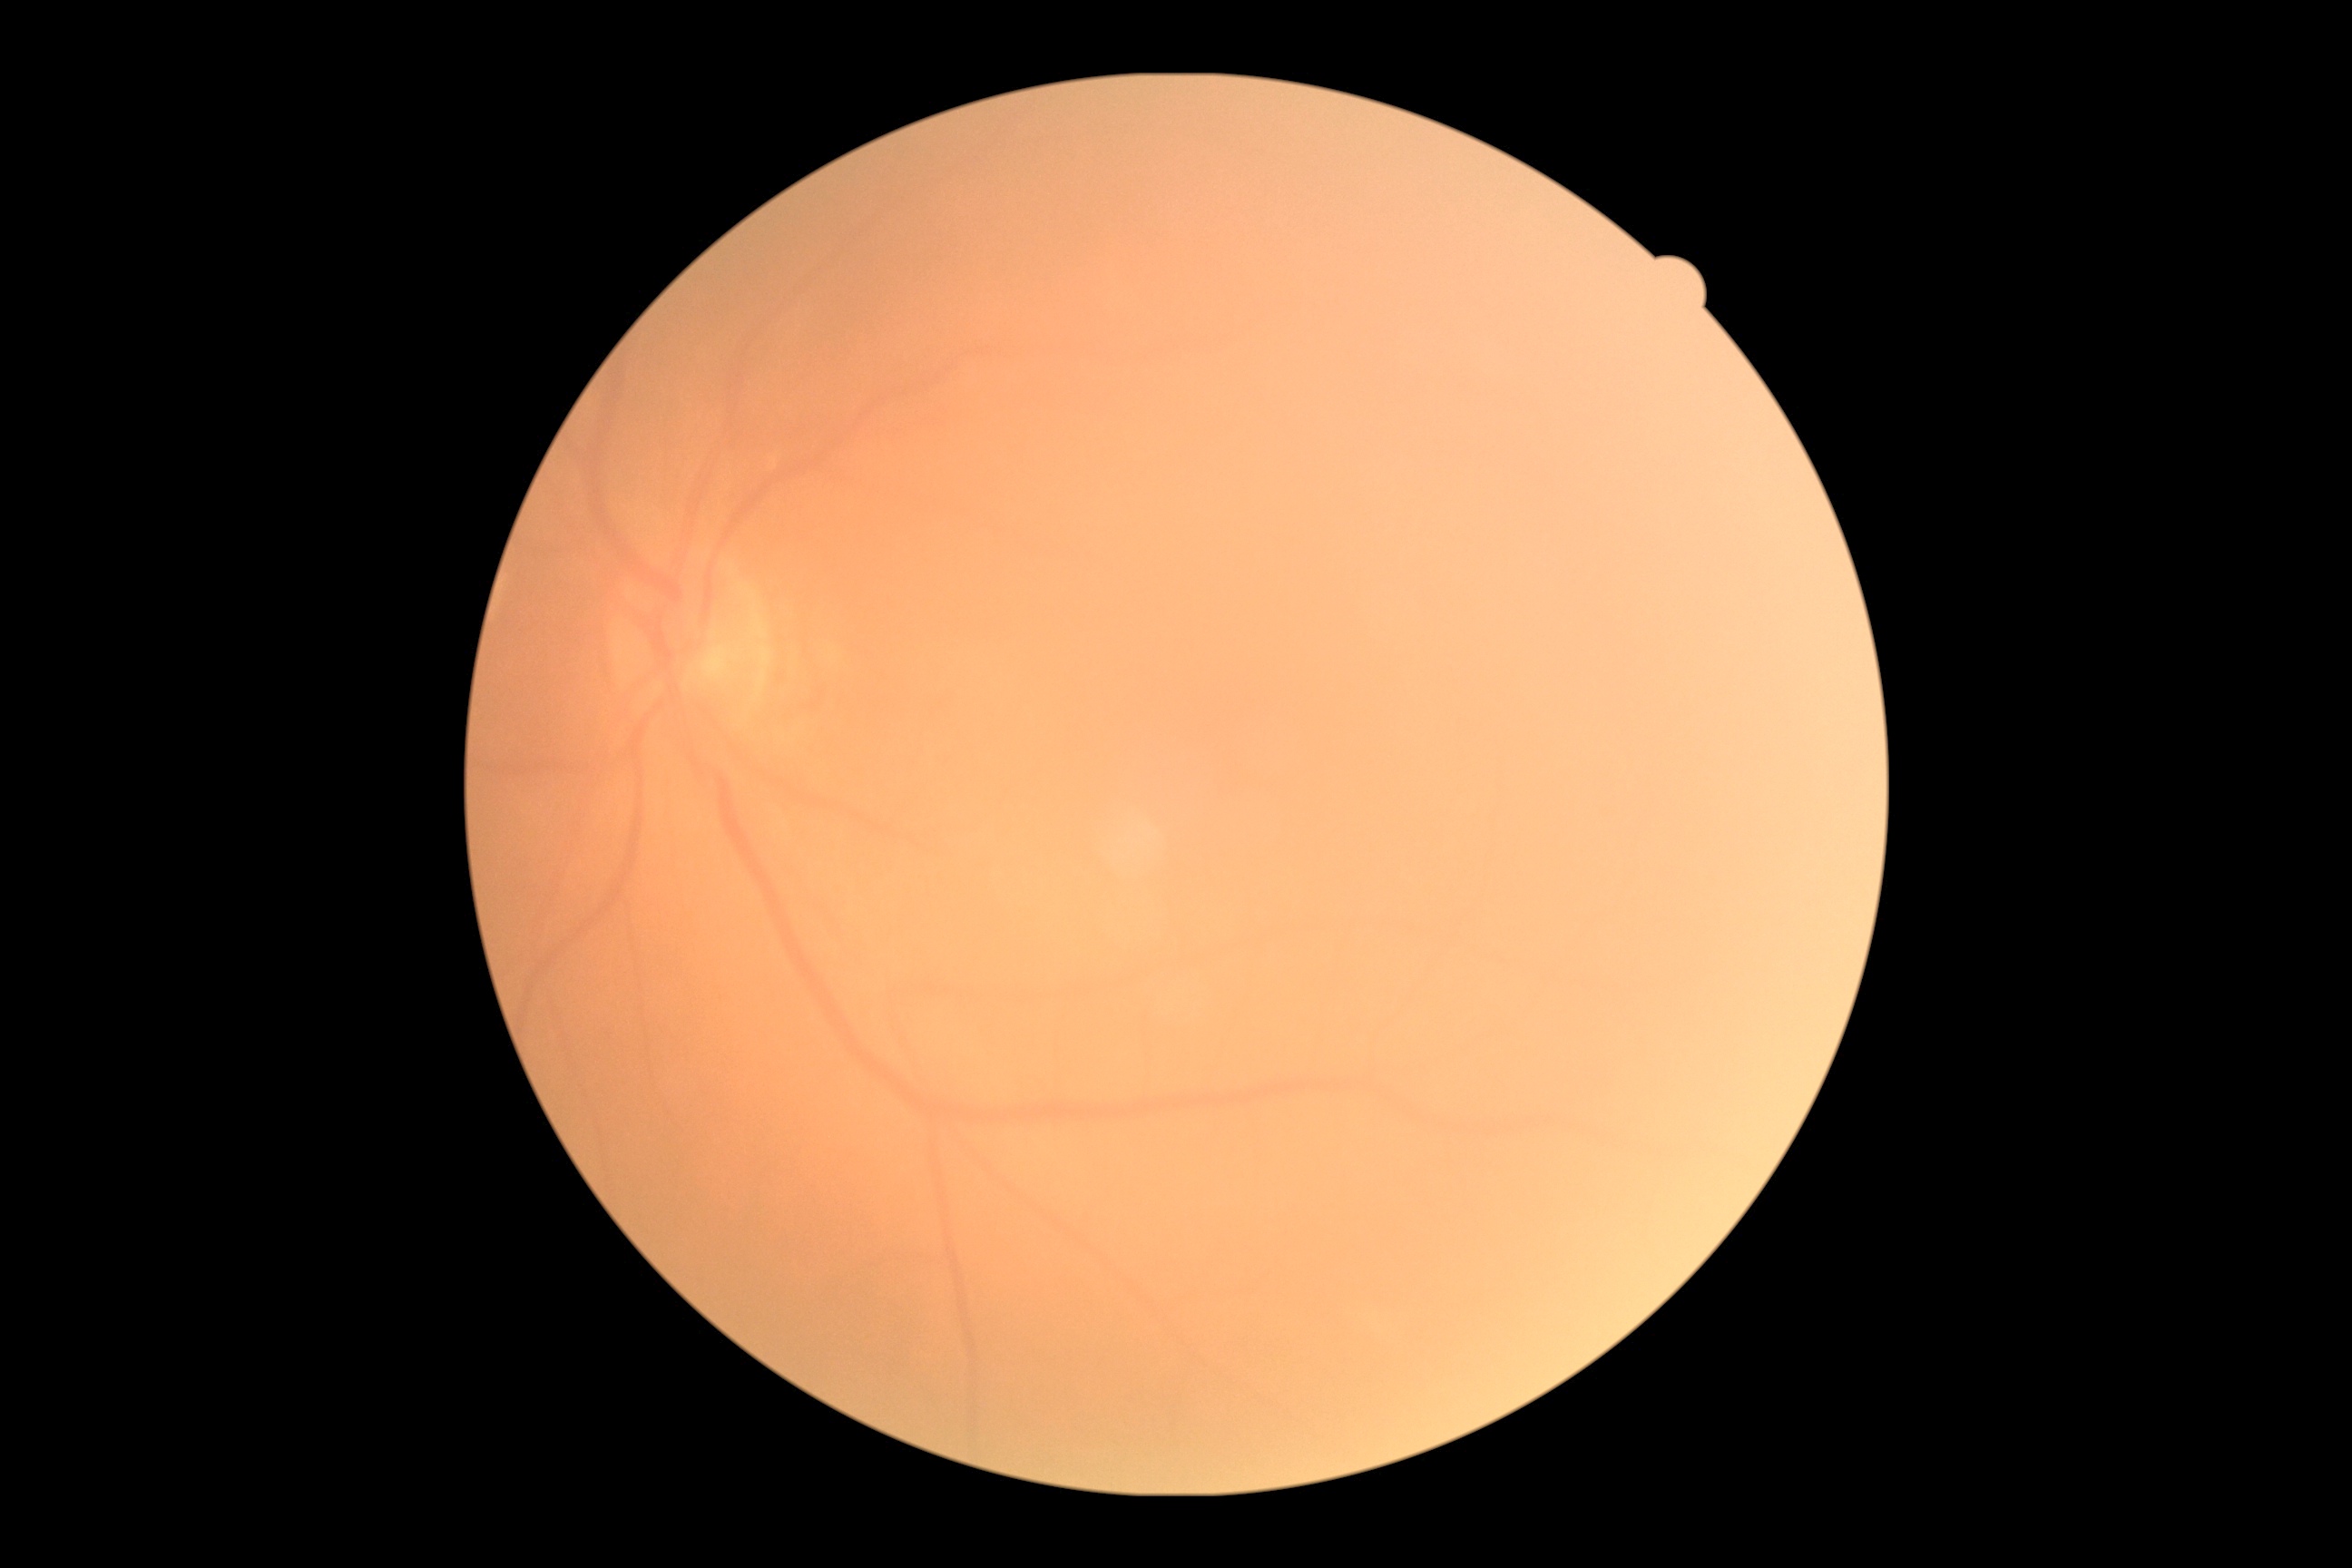
Diabetic retinopathy (DR) is grade 0.